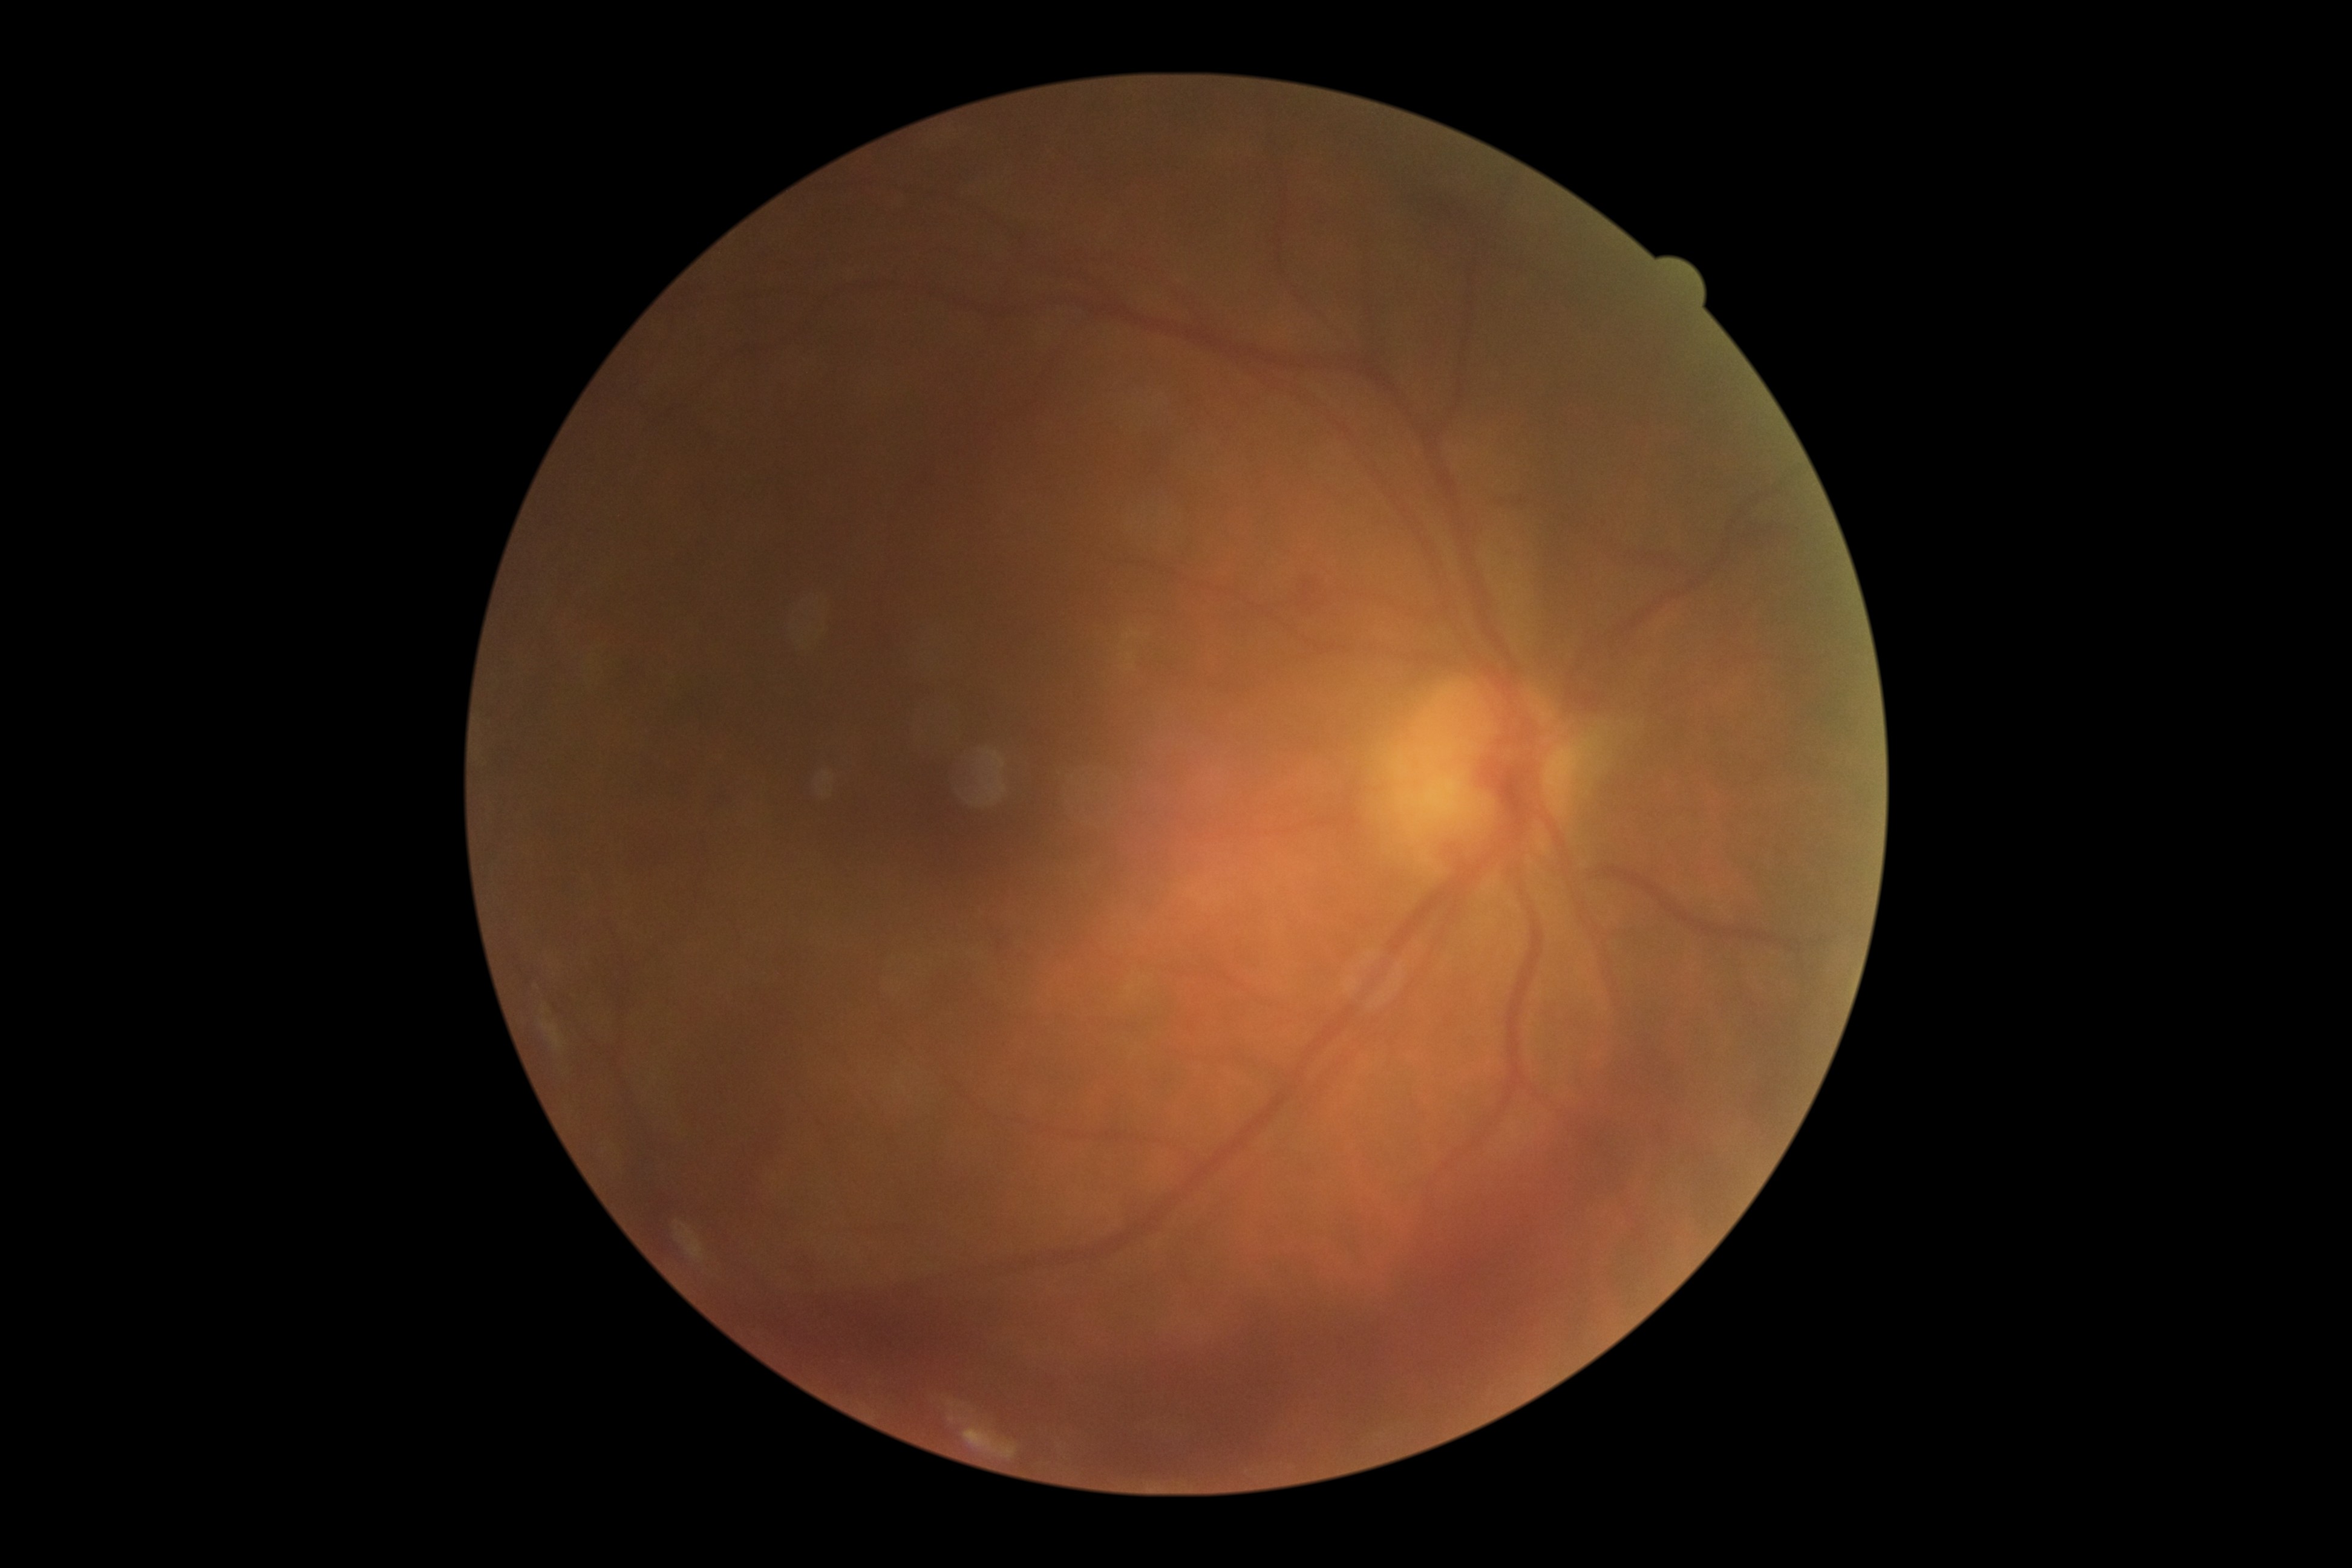

- DR class — proliferative diabetic retinopathy
- diabetic retinopathy grade — proliferative diabetic retinopathy (4)